Color fundus image · image size 848x848 · 45-degree field of view · no pharmacologic dilation: 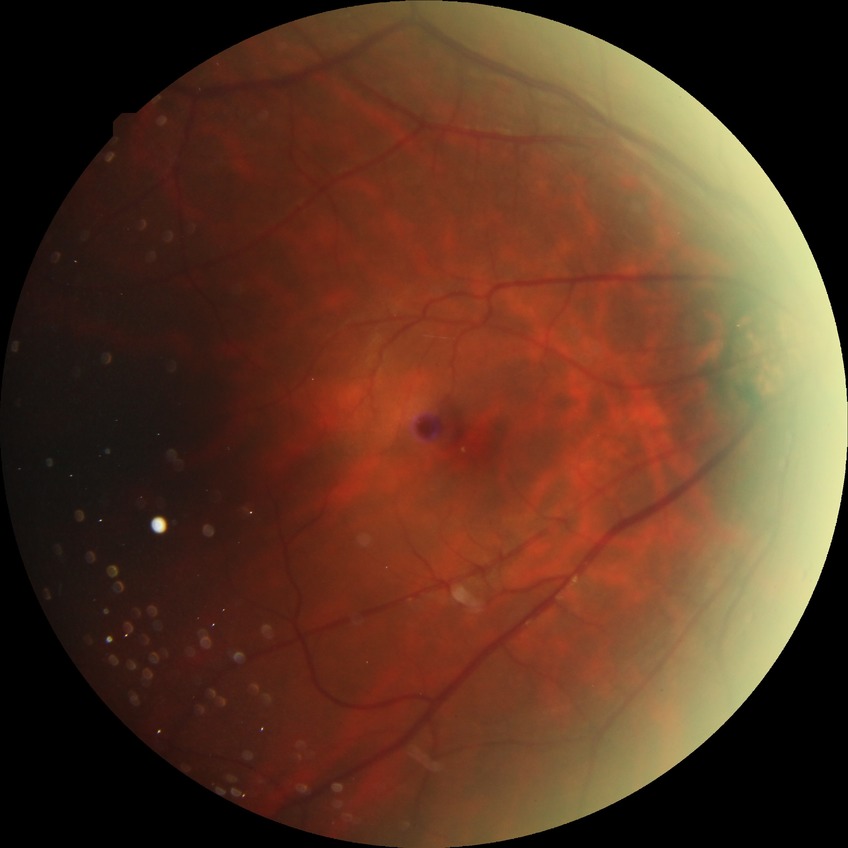 No diabetic retinal disease findings.
DR stage: NDR.